NIDEK AFC-230
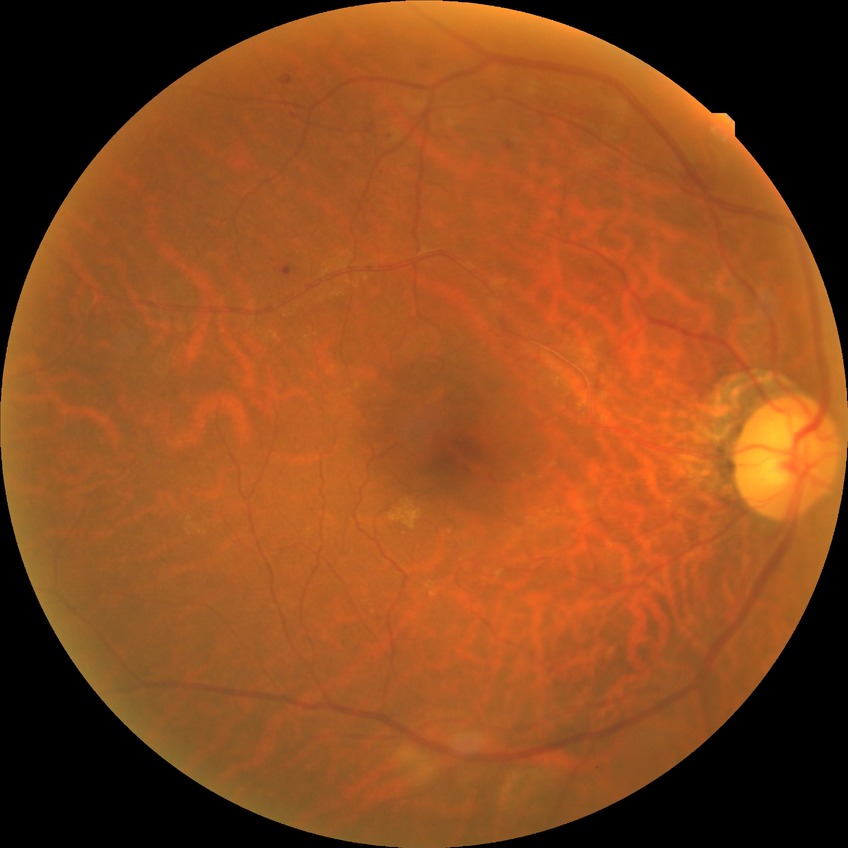
Davis stage = SDR.